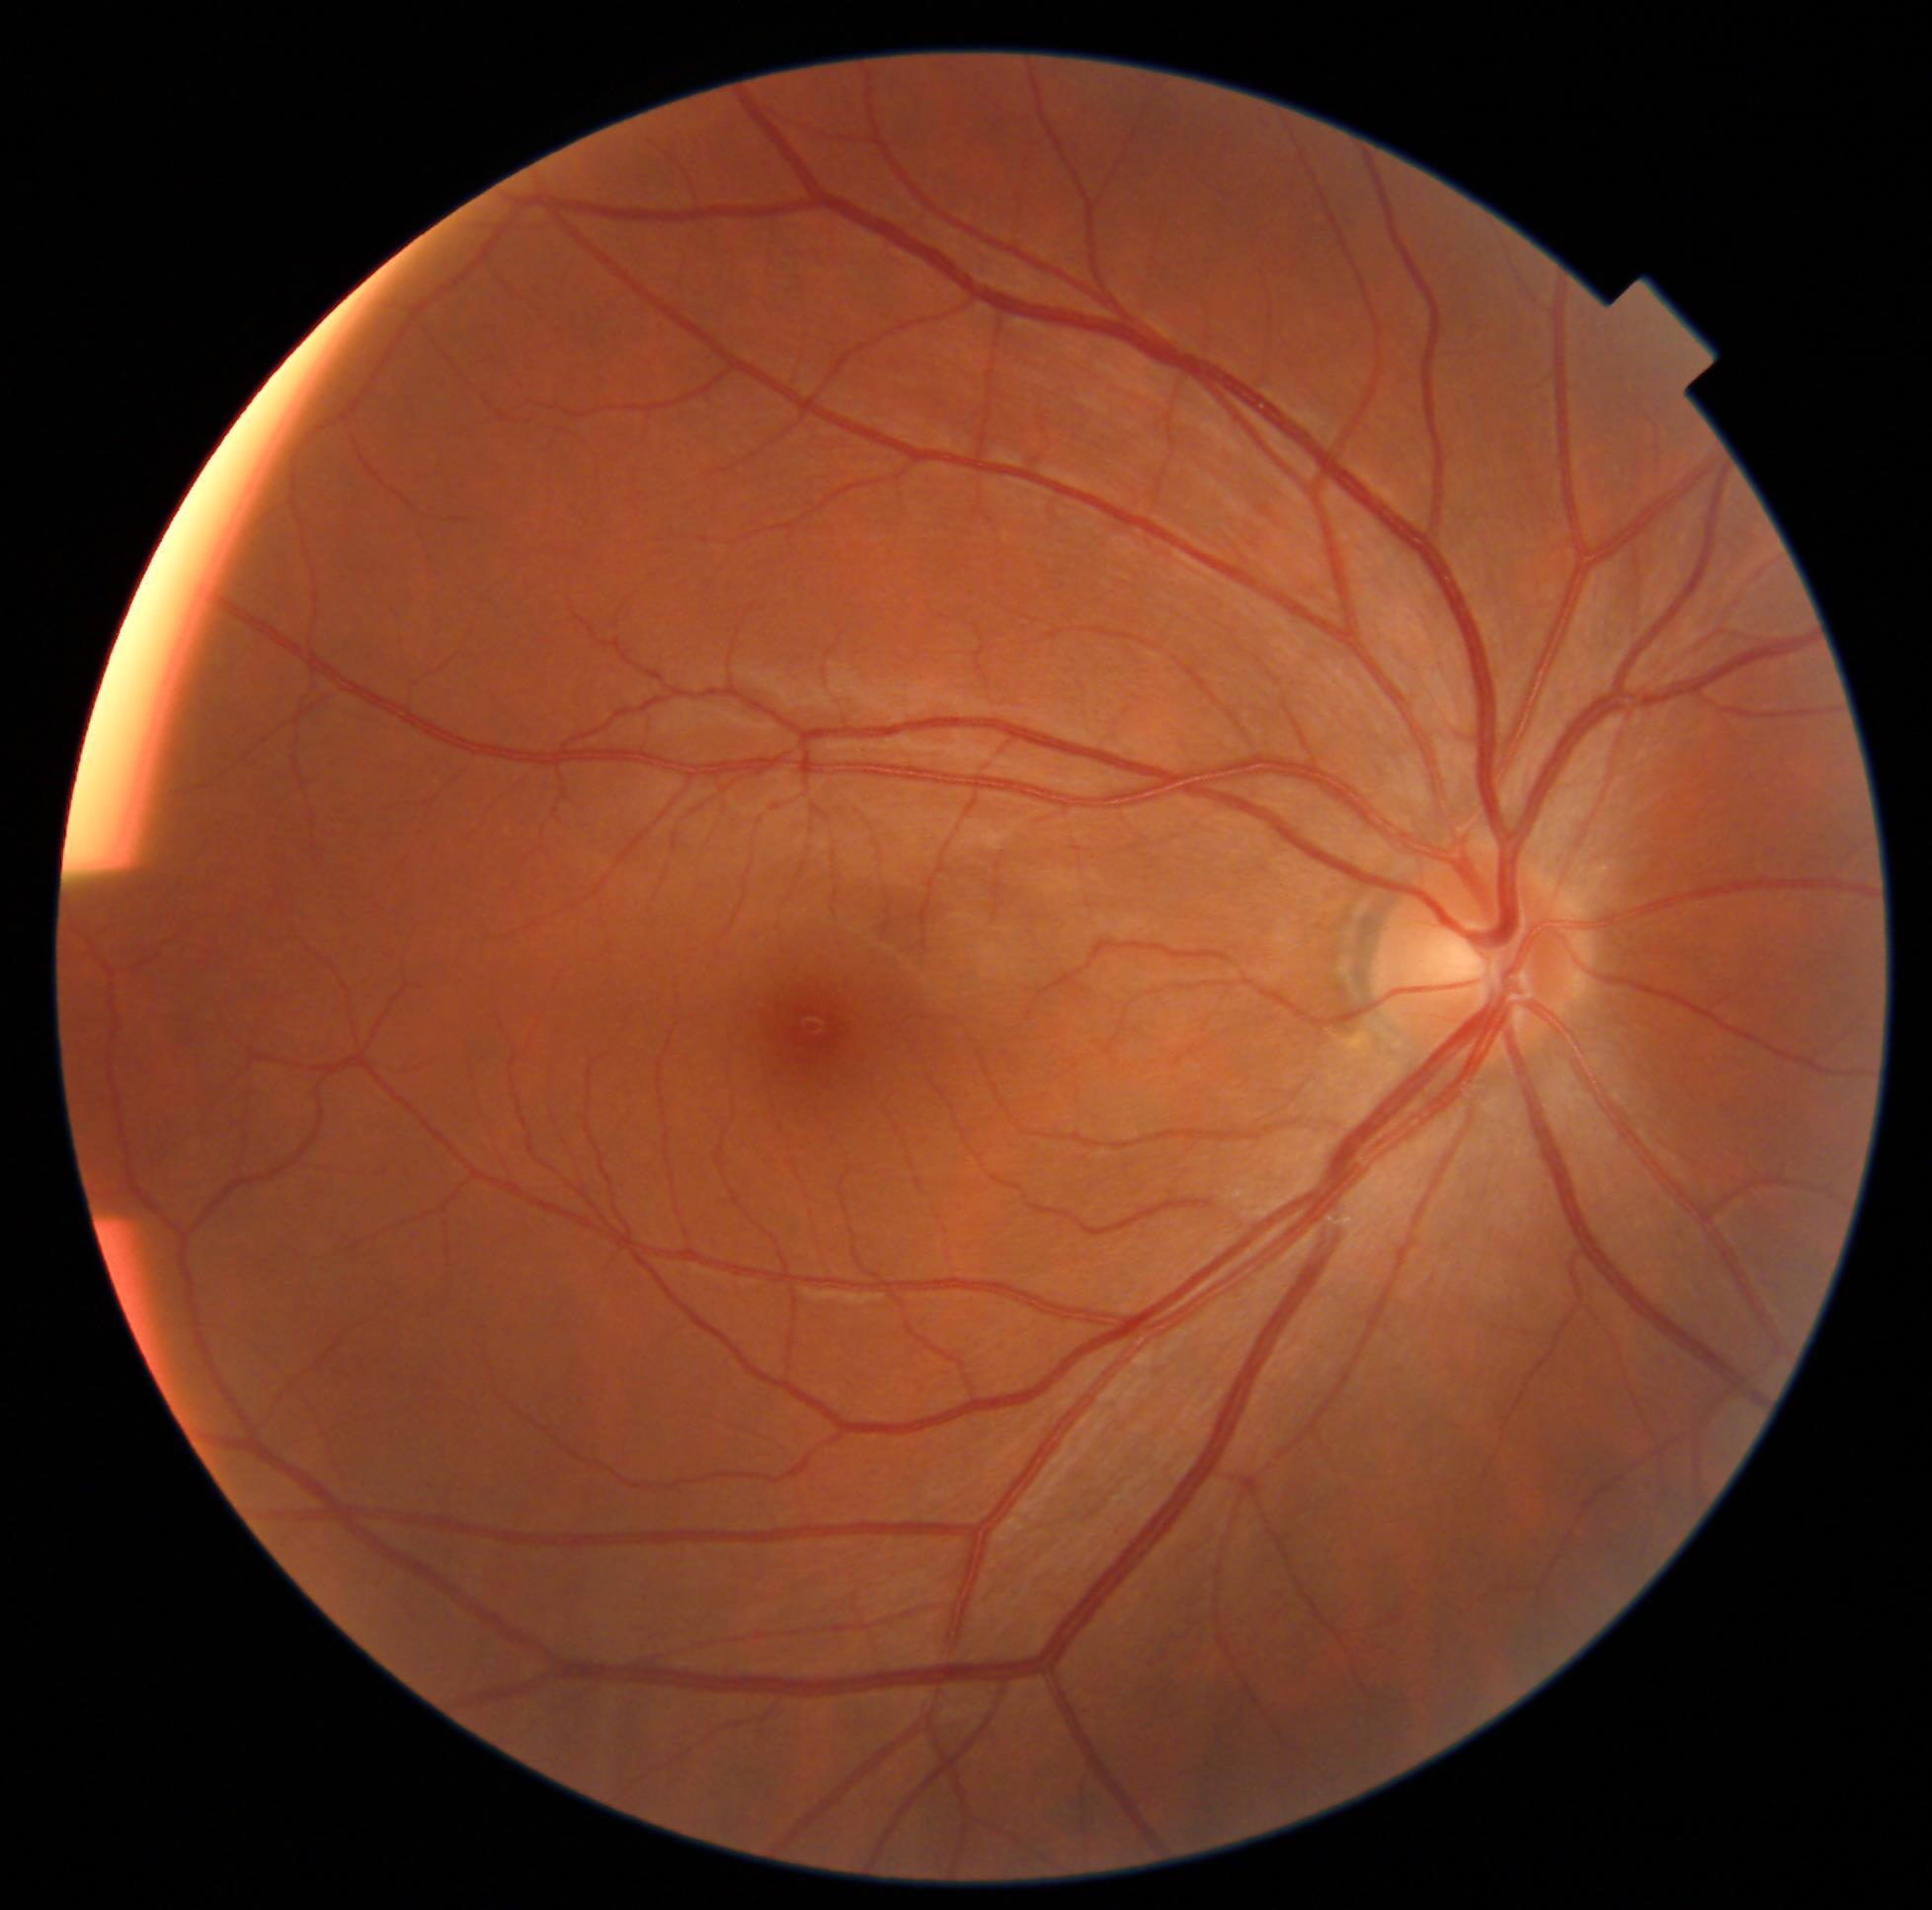

Diabetic retinopathy (DR) is 0 — no visible signs of diabetic retinopathy.